CFP — 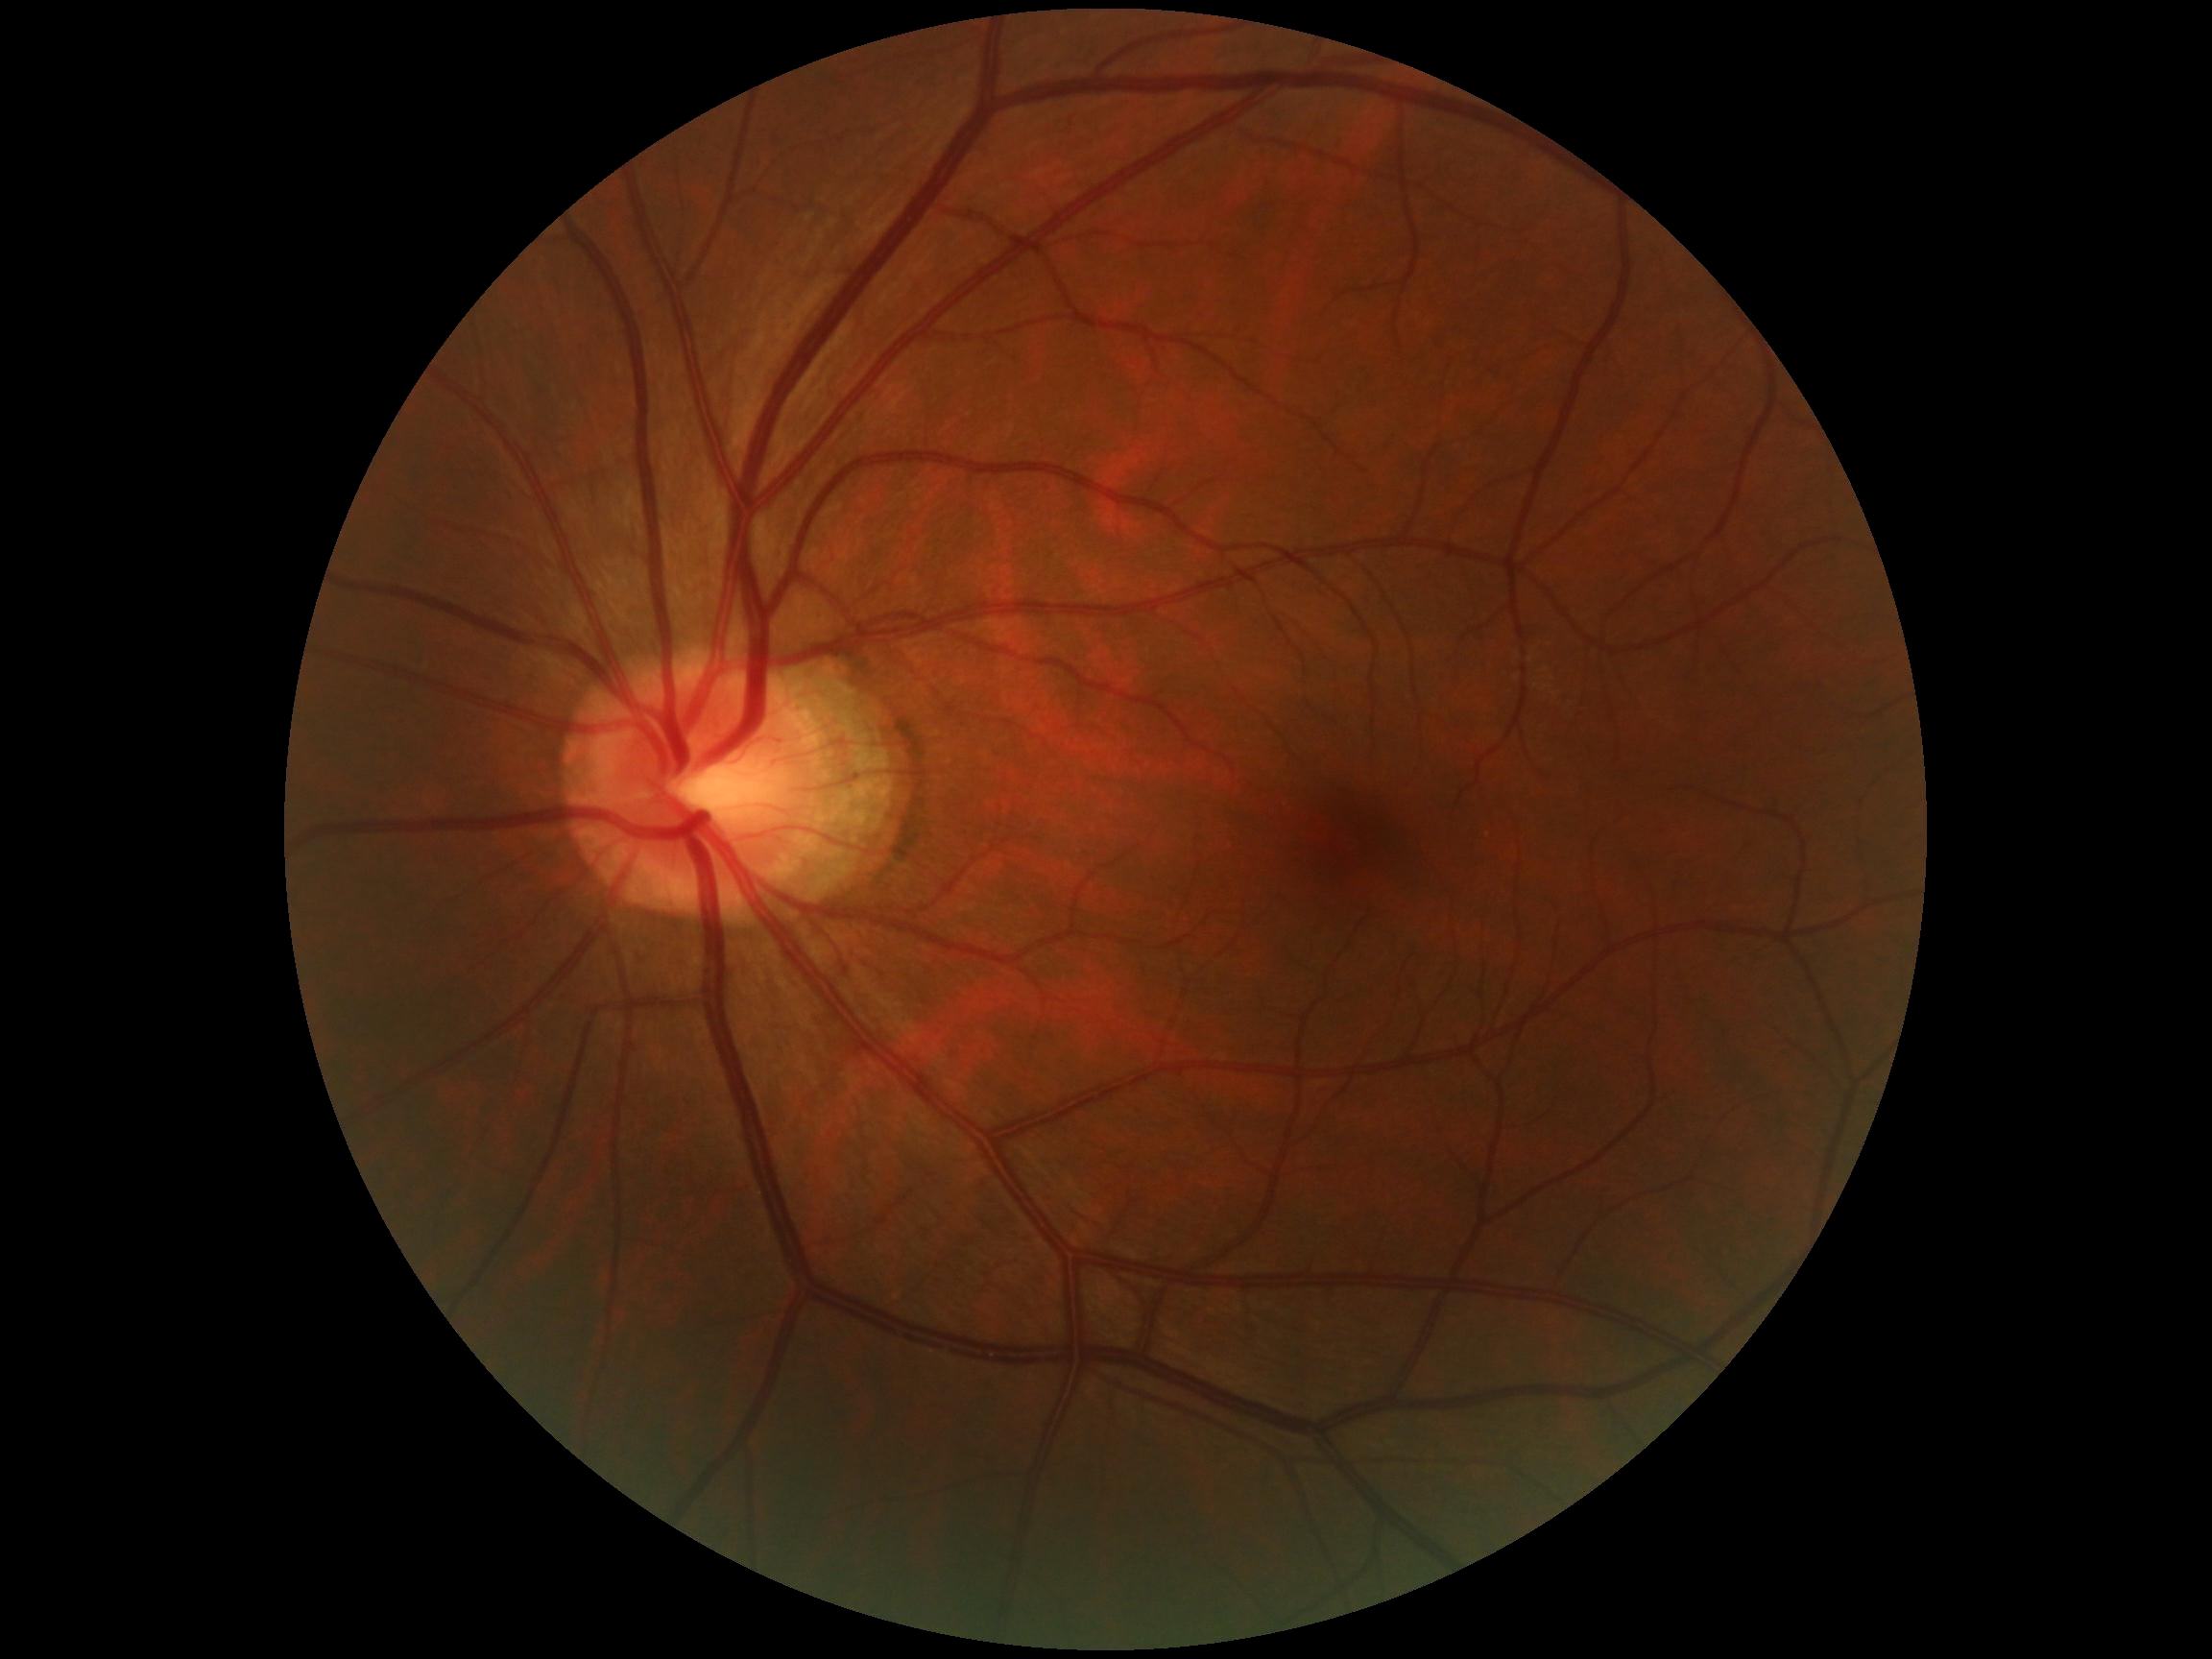

Annotations:
• DR: 0/4